Davis DR grading: 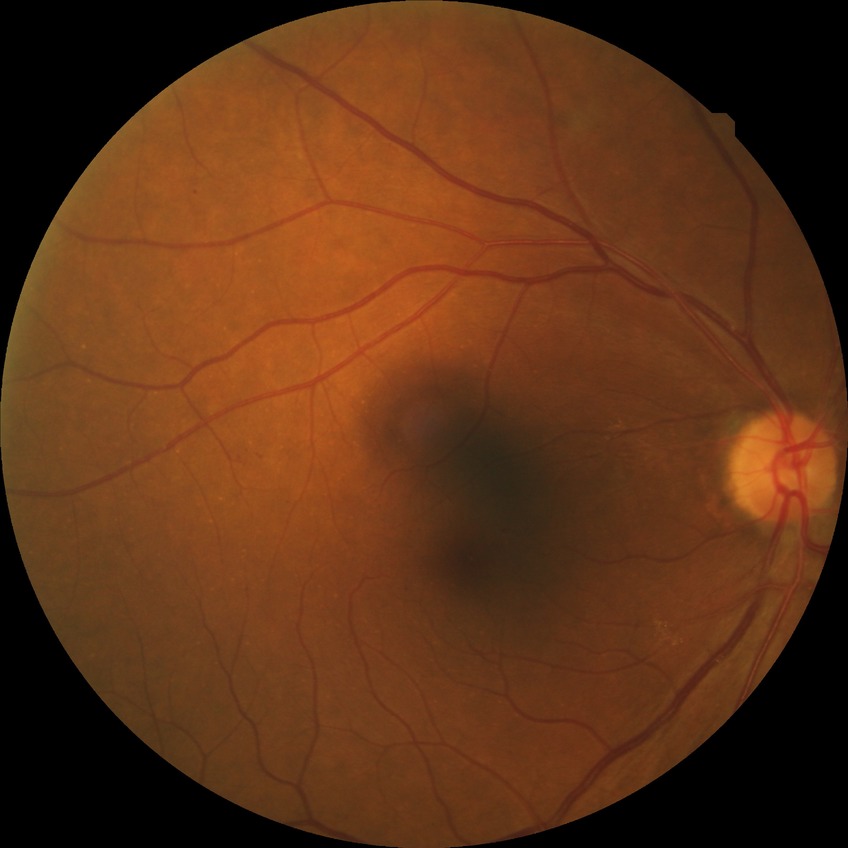

Modified Davis classification: simple diabetic retinopathy. DR class: non-proliferative diabetic retinopathy.